45° field of view; fundus photo.
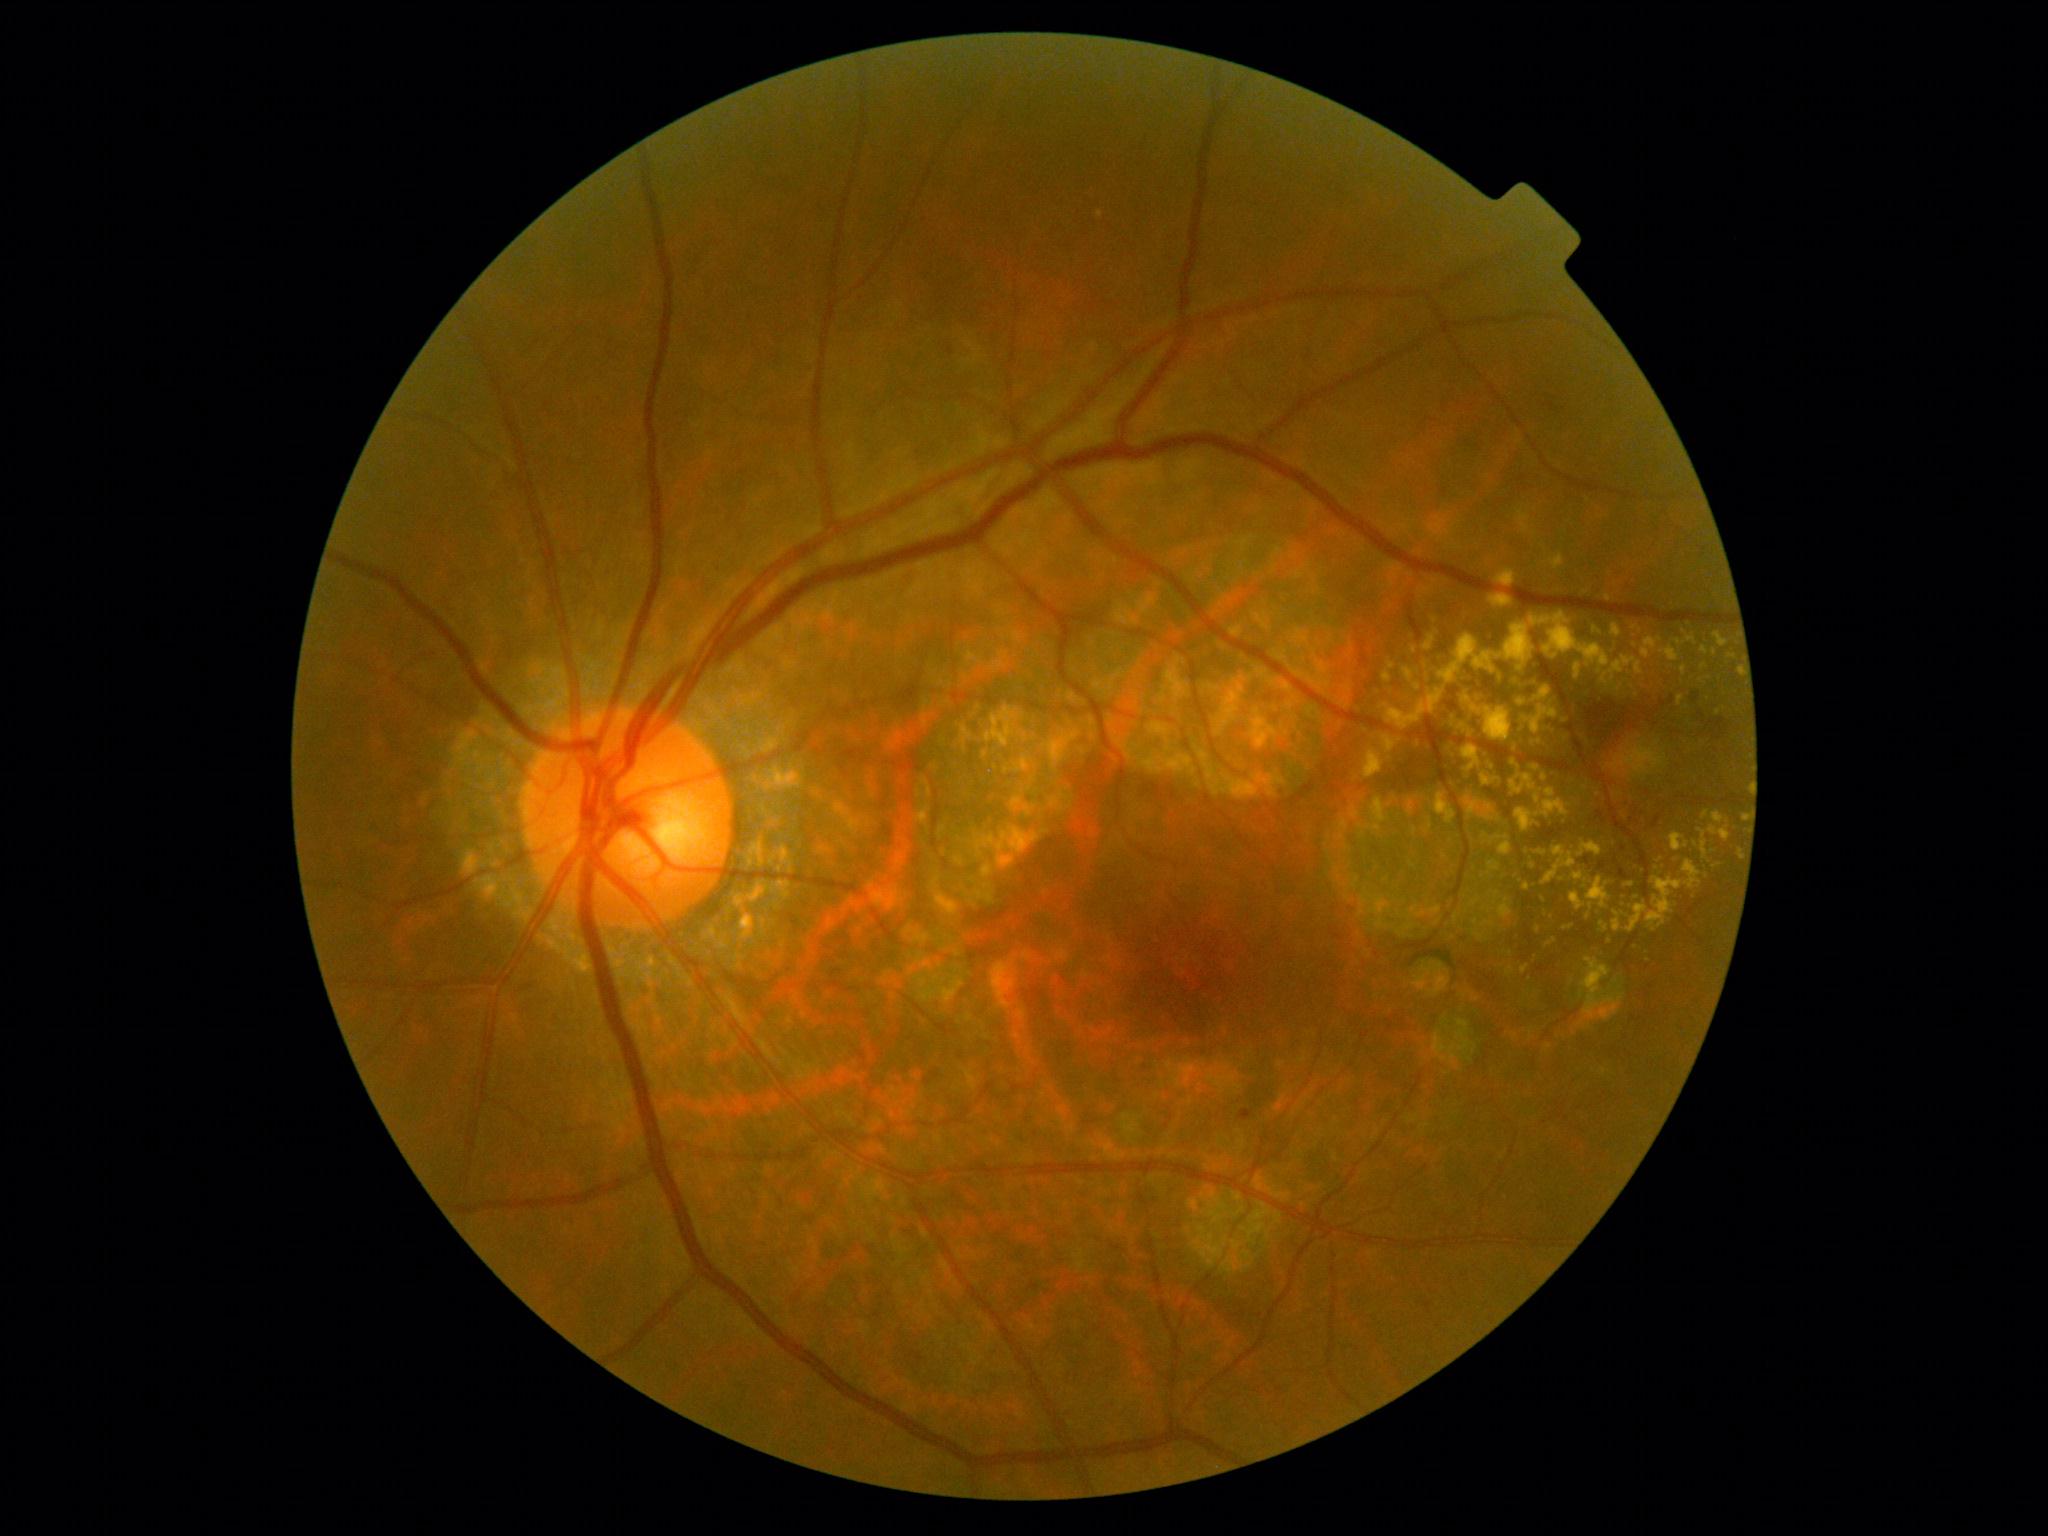 {"partial":true,"dr_grade":2,"dr_grade_name":"moderate NPDR","lesions":{"ex":[[1703,811,1710,819],[1576,841,1602,858],[1687,635,1697,645],[1489,595,1513,608],[1380,689,1446,730],[1523,706,1559,736],[1612,911,1622,933],[1584,957,1595,963],[1535,686,1552,702],[1532,739,1542,745],[1611,624,1622,638],[1466,796,1483,819]],"ex_small":[[1678,643],[1696,845],[1591,907],[1637,695],[1715,652],[1701,681],[1563,880]]}}